Mydriatic (tropicamide and phenylephrine) · CFP: 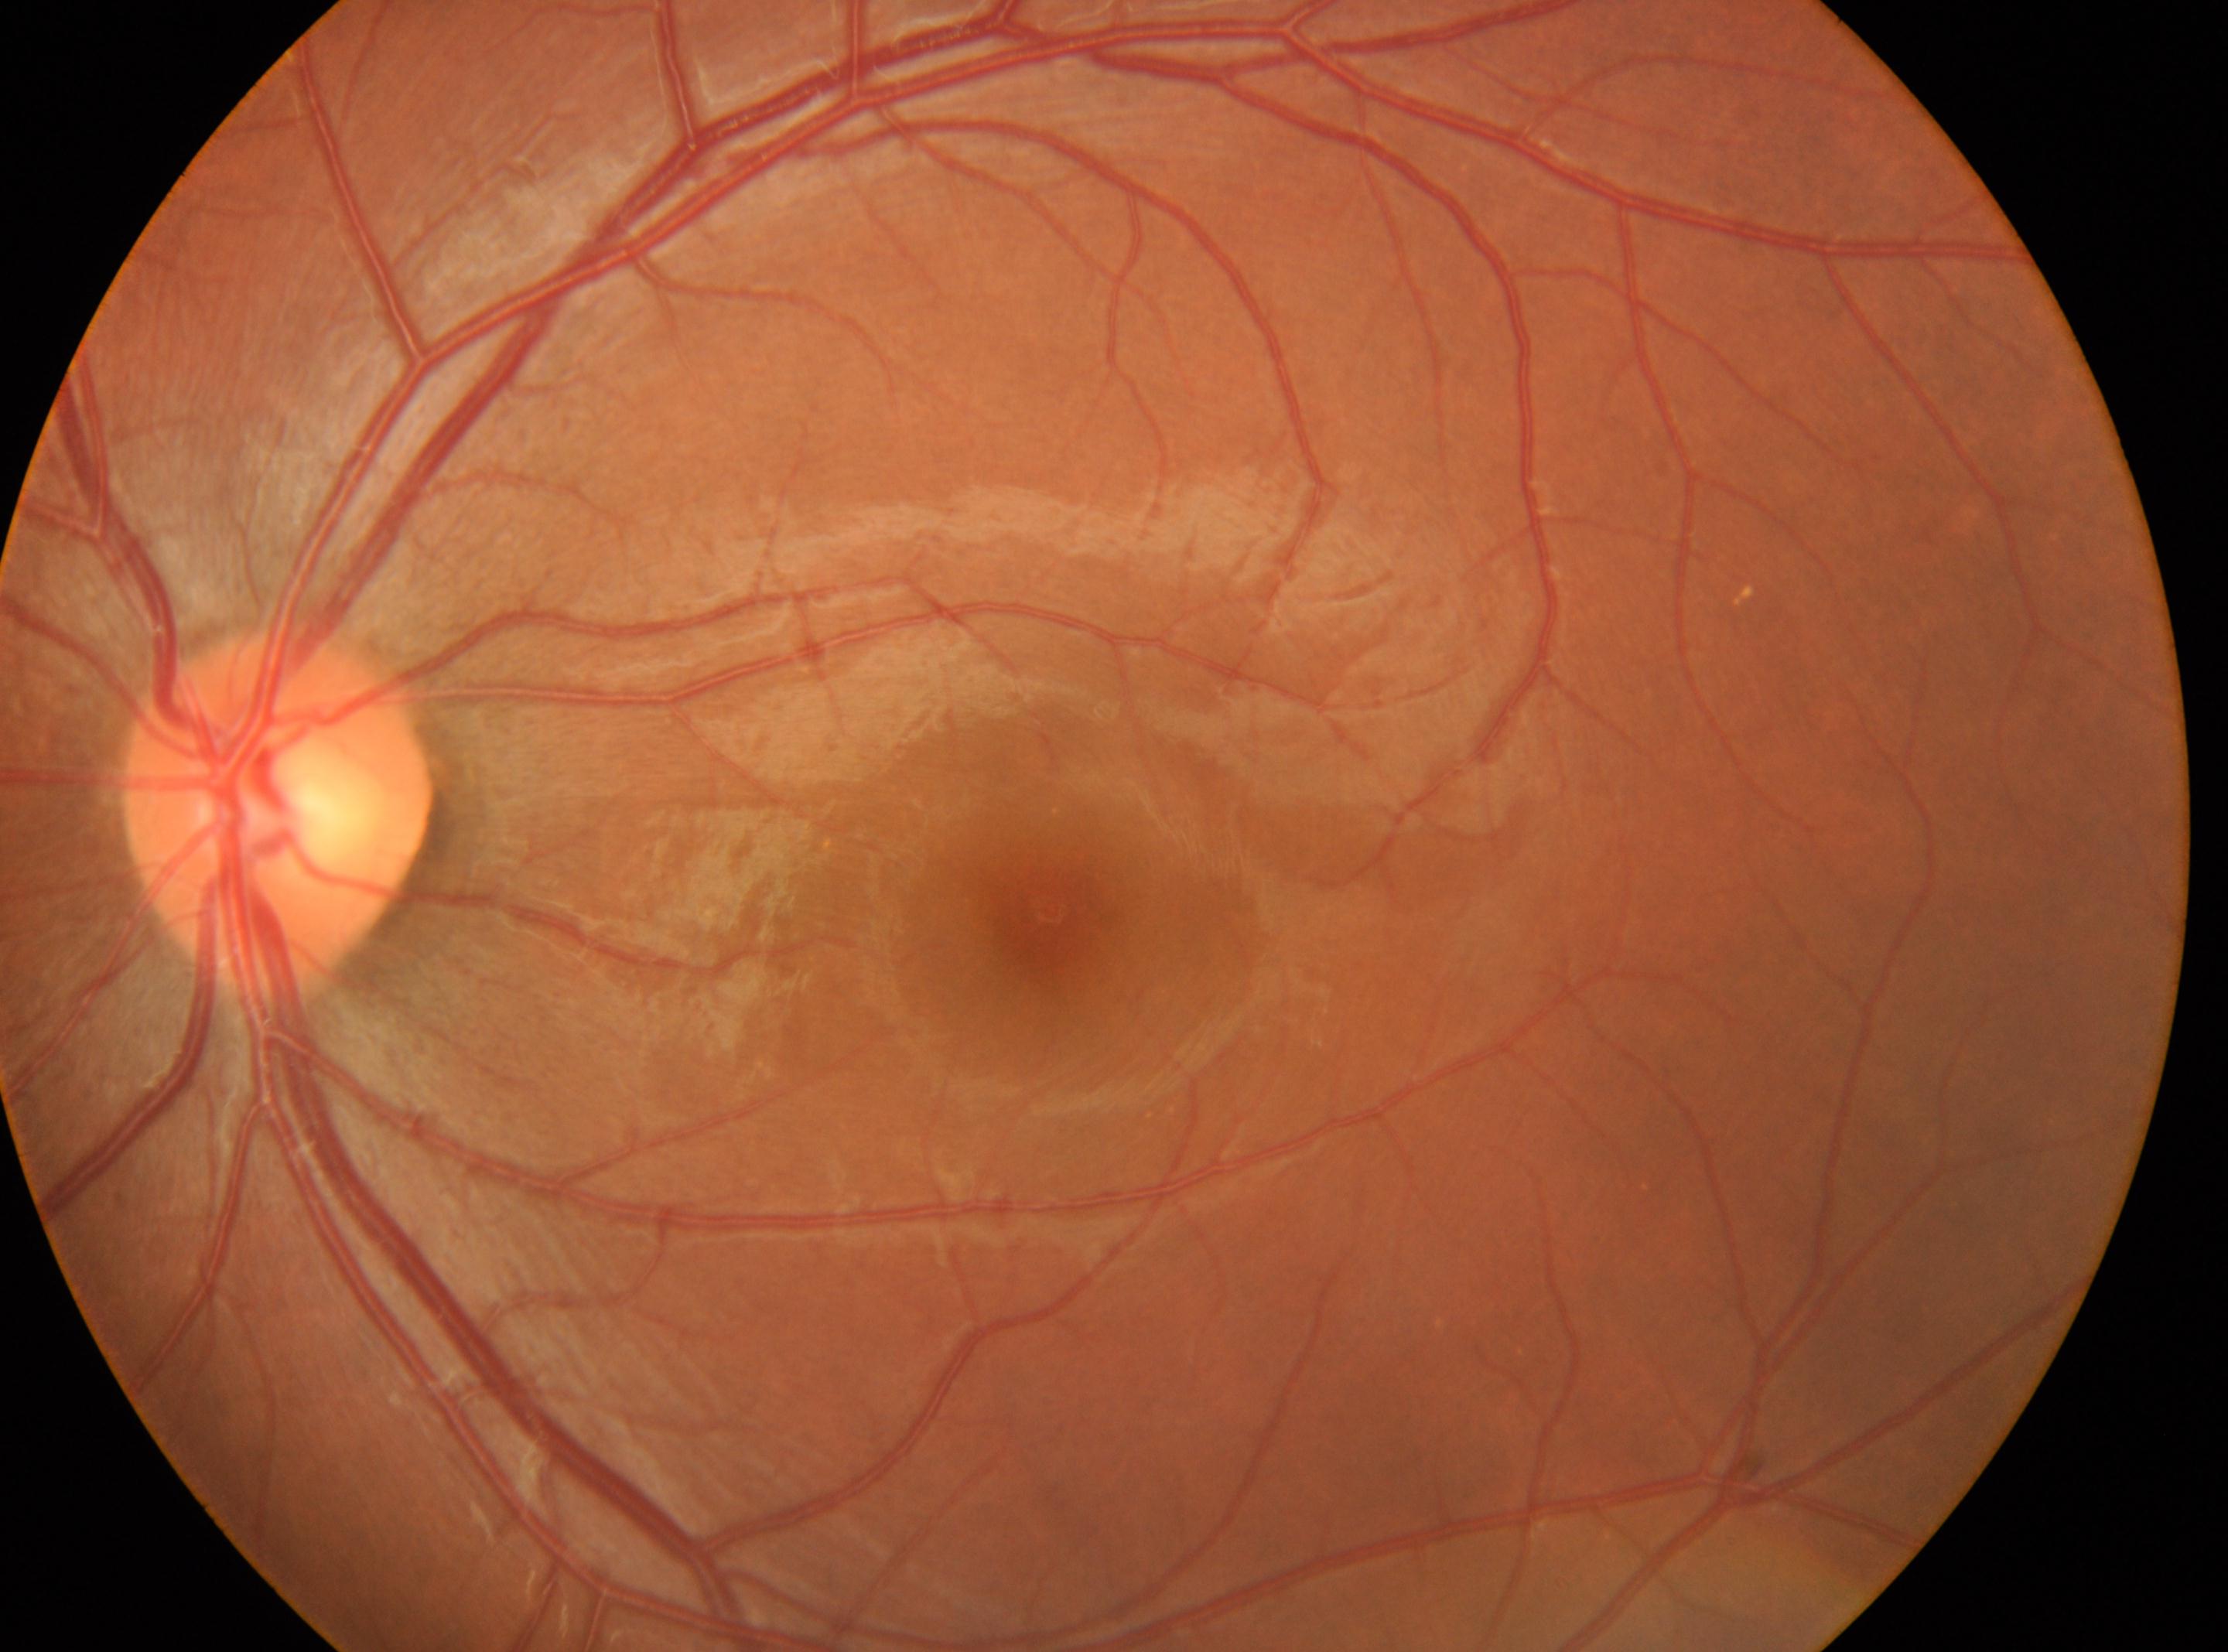

The macular center is at x=1051, y=908. Imaged eye: OS. Optic disc located at x=277, y=811. No diabetic retinopathy identified. Diabetic retinopathy (DR): grade 0 (no apparent retinopathy).